848x848px · nonmydriatic — 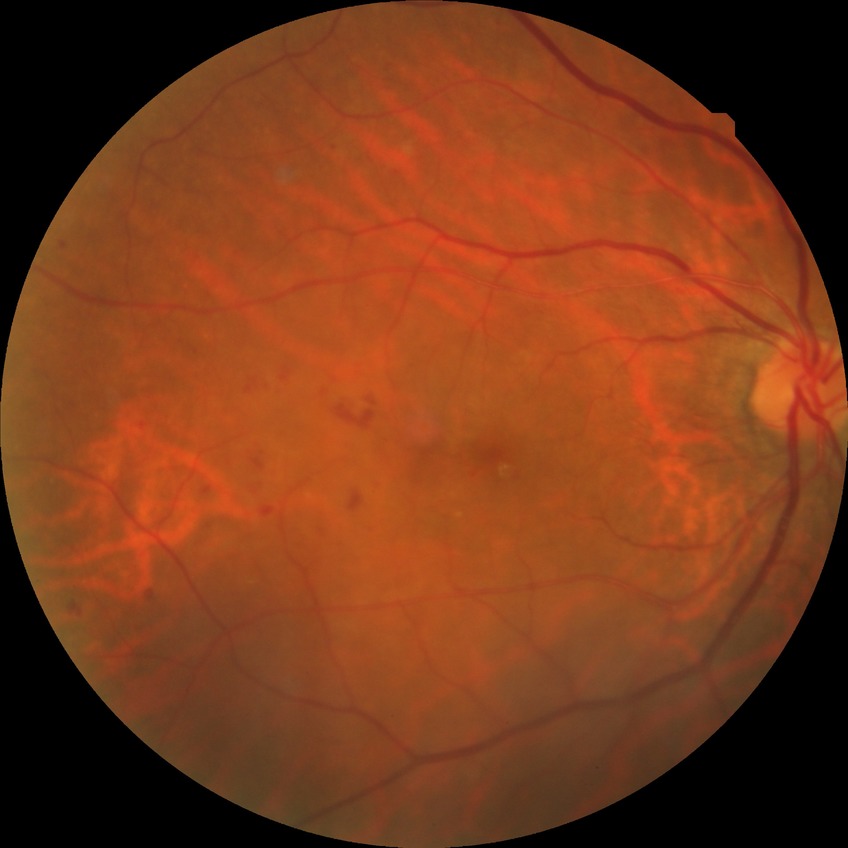
Davis stage = SDR.